1960 x 1897 pixels · fundus photo — 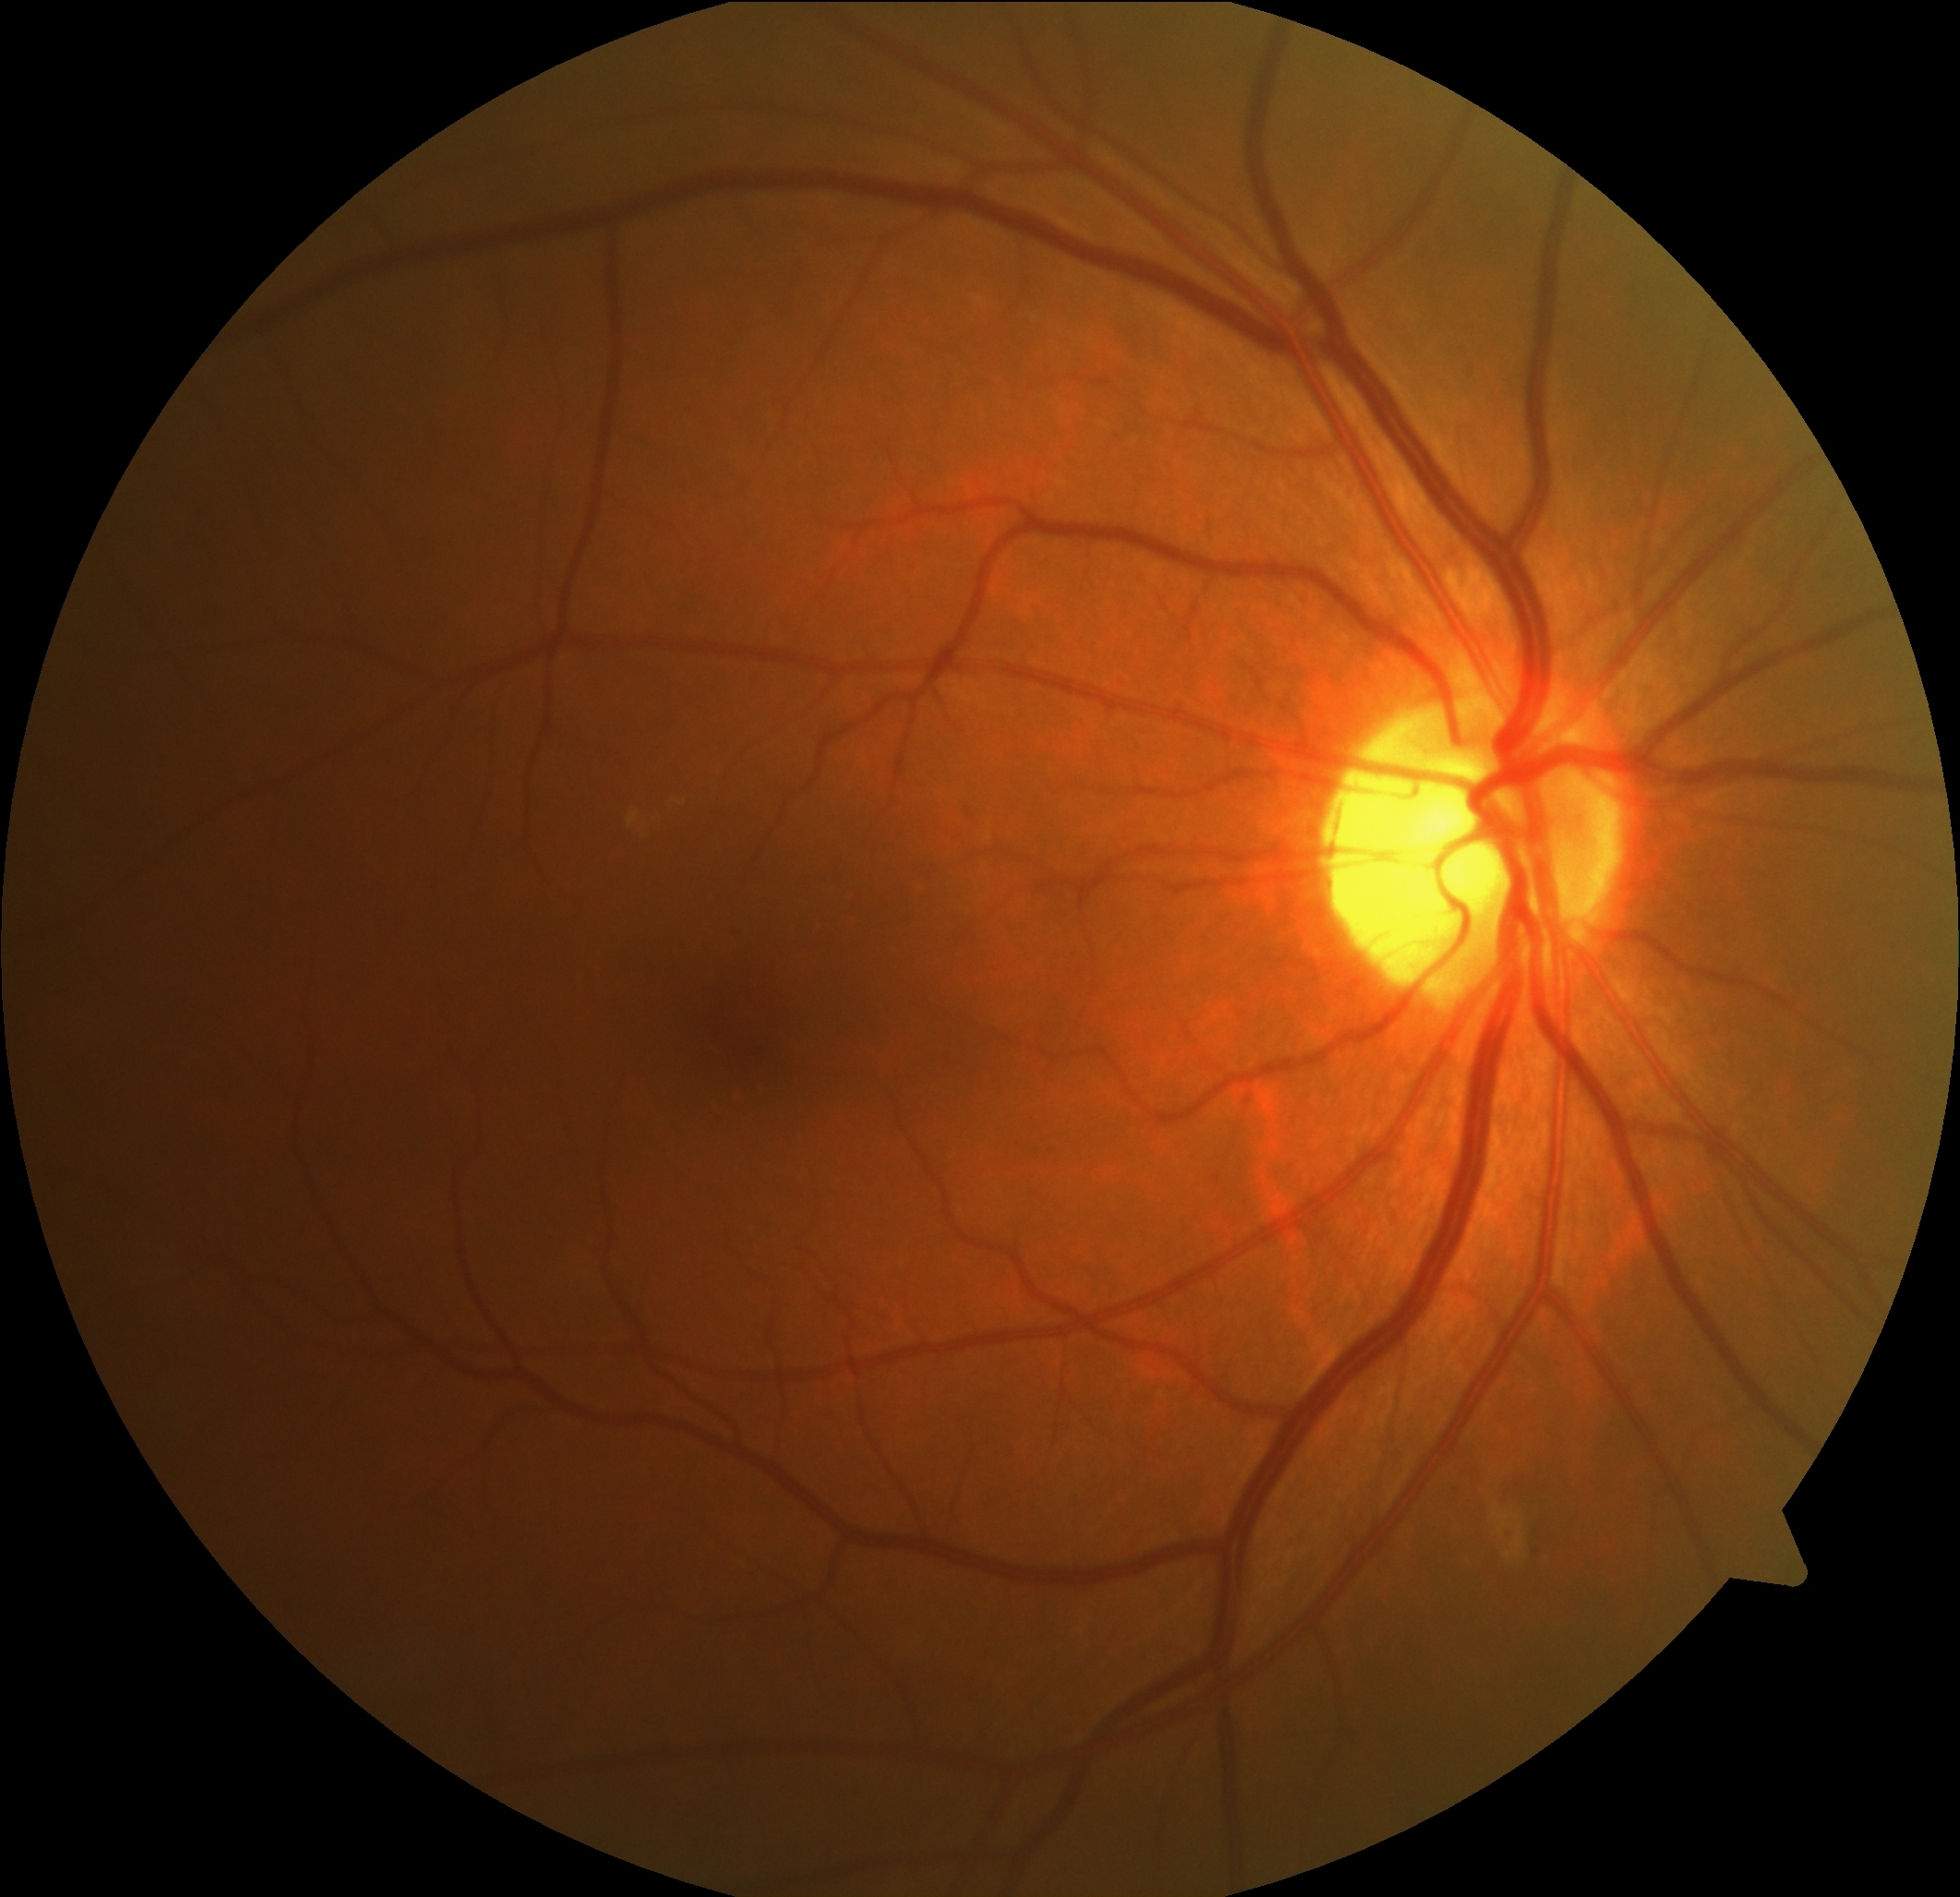

DR stage: 2.